Image size 2212x1659: 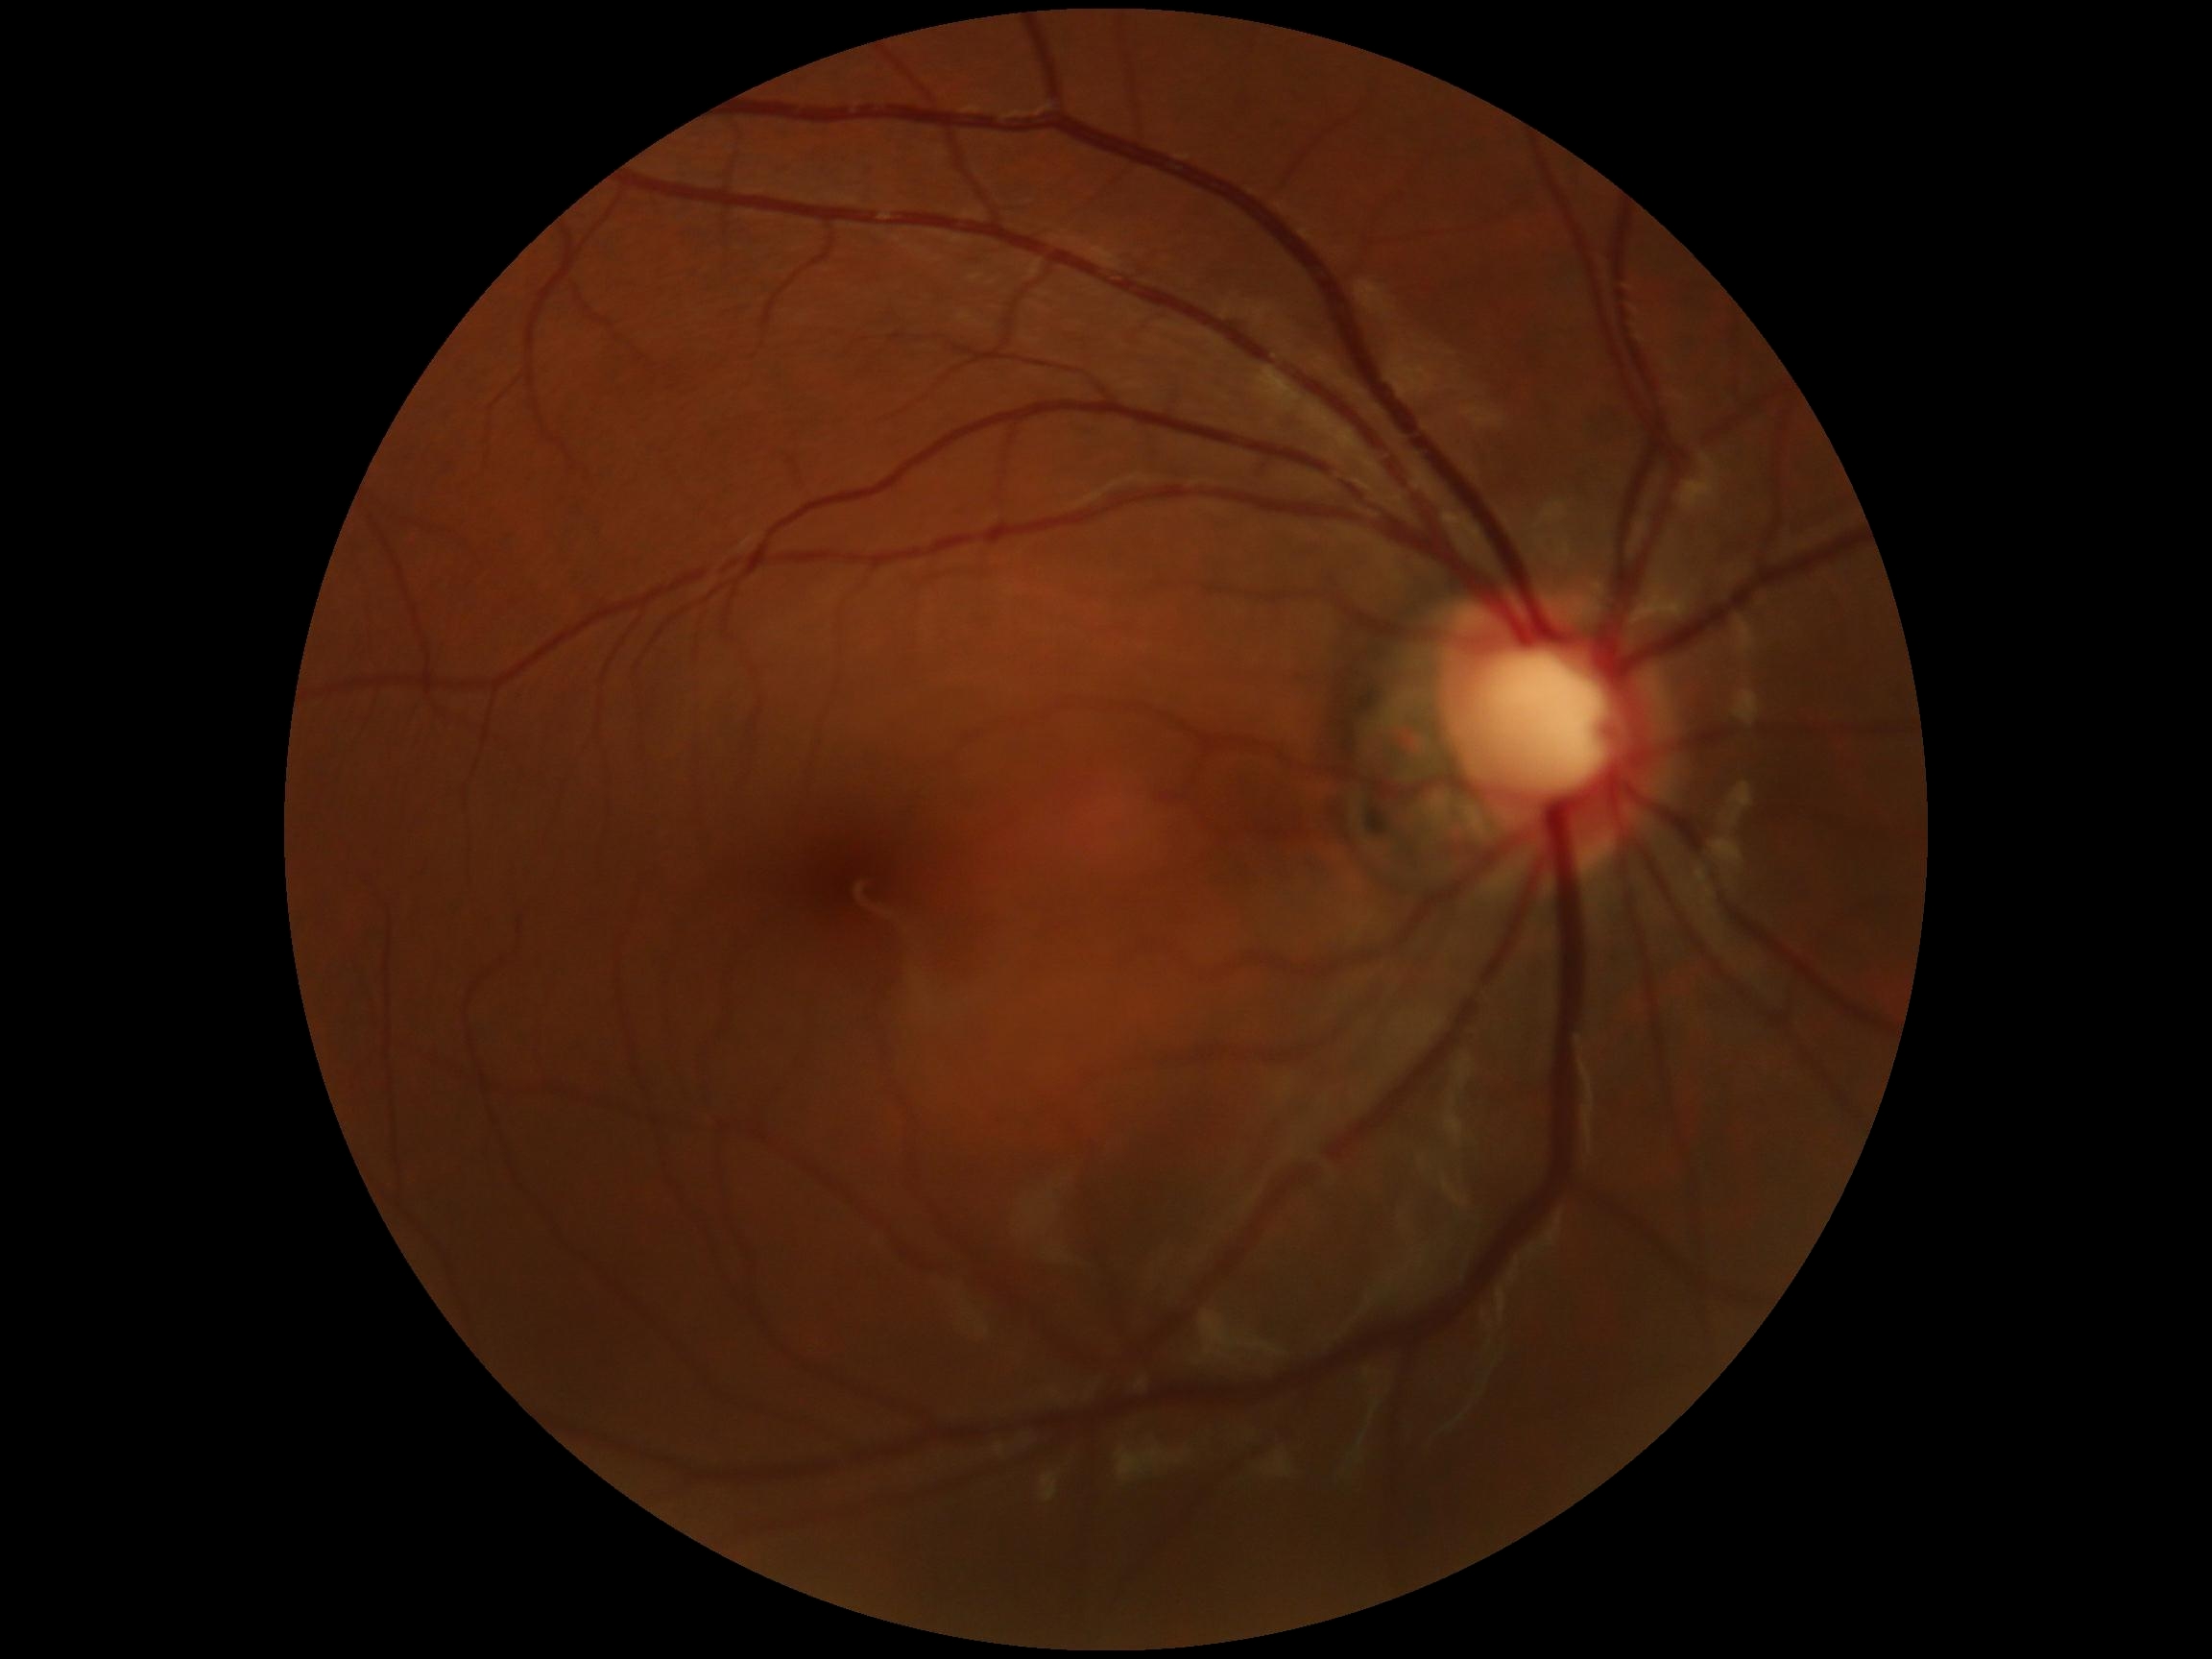 DR stage@grade 0 (no apparent retinopathy).